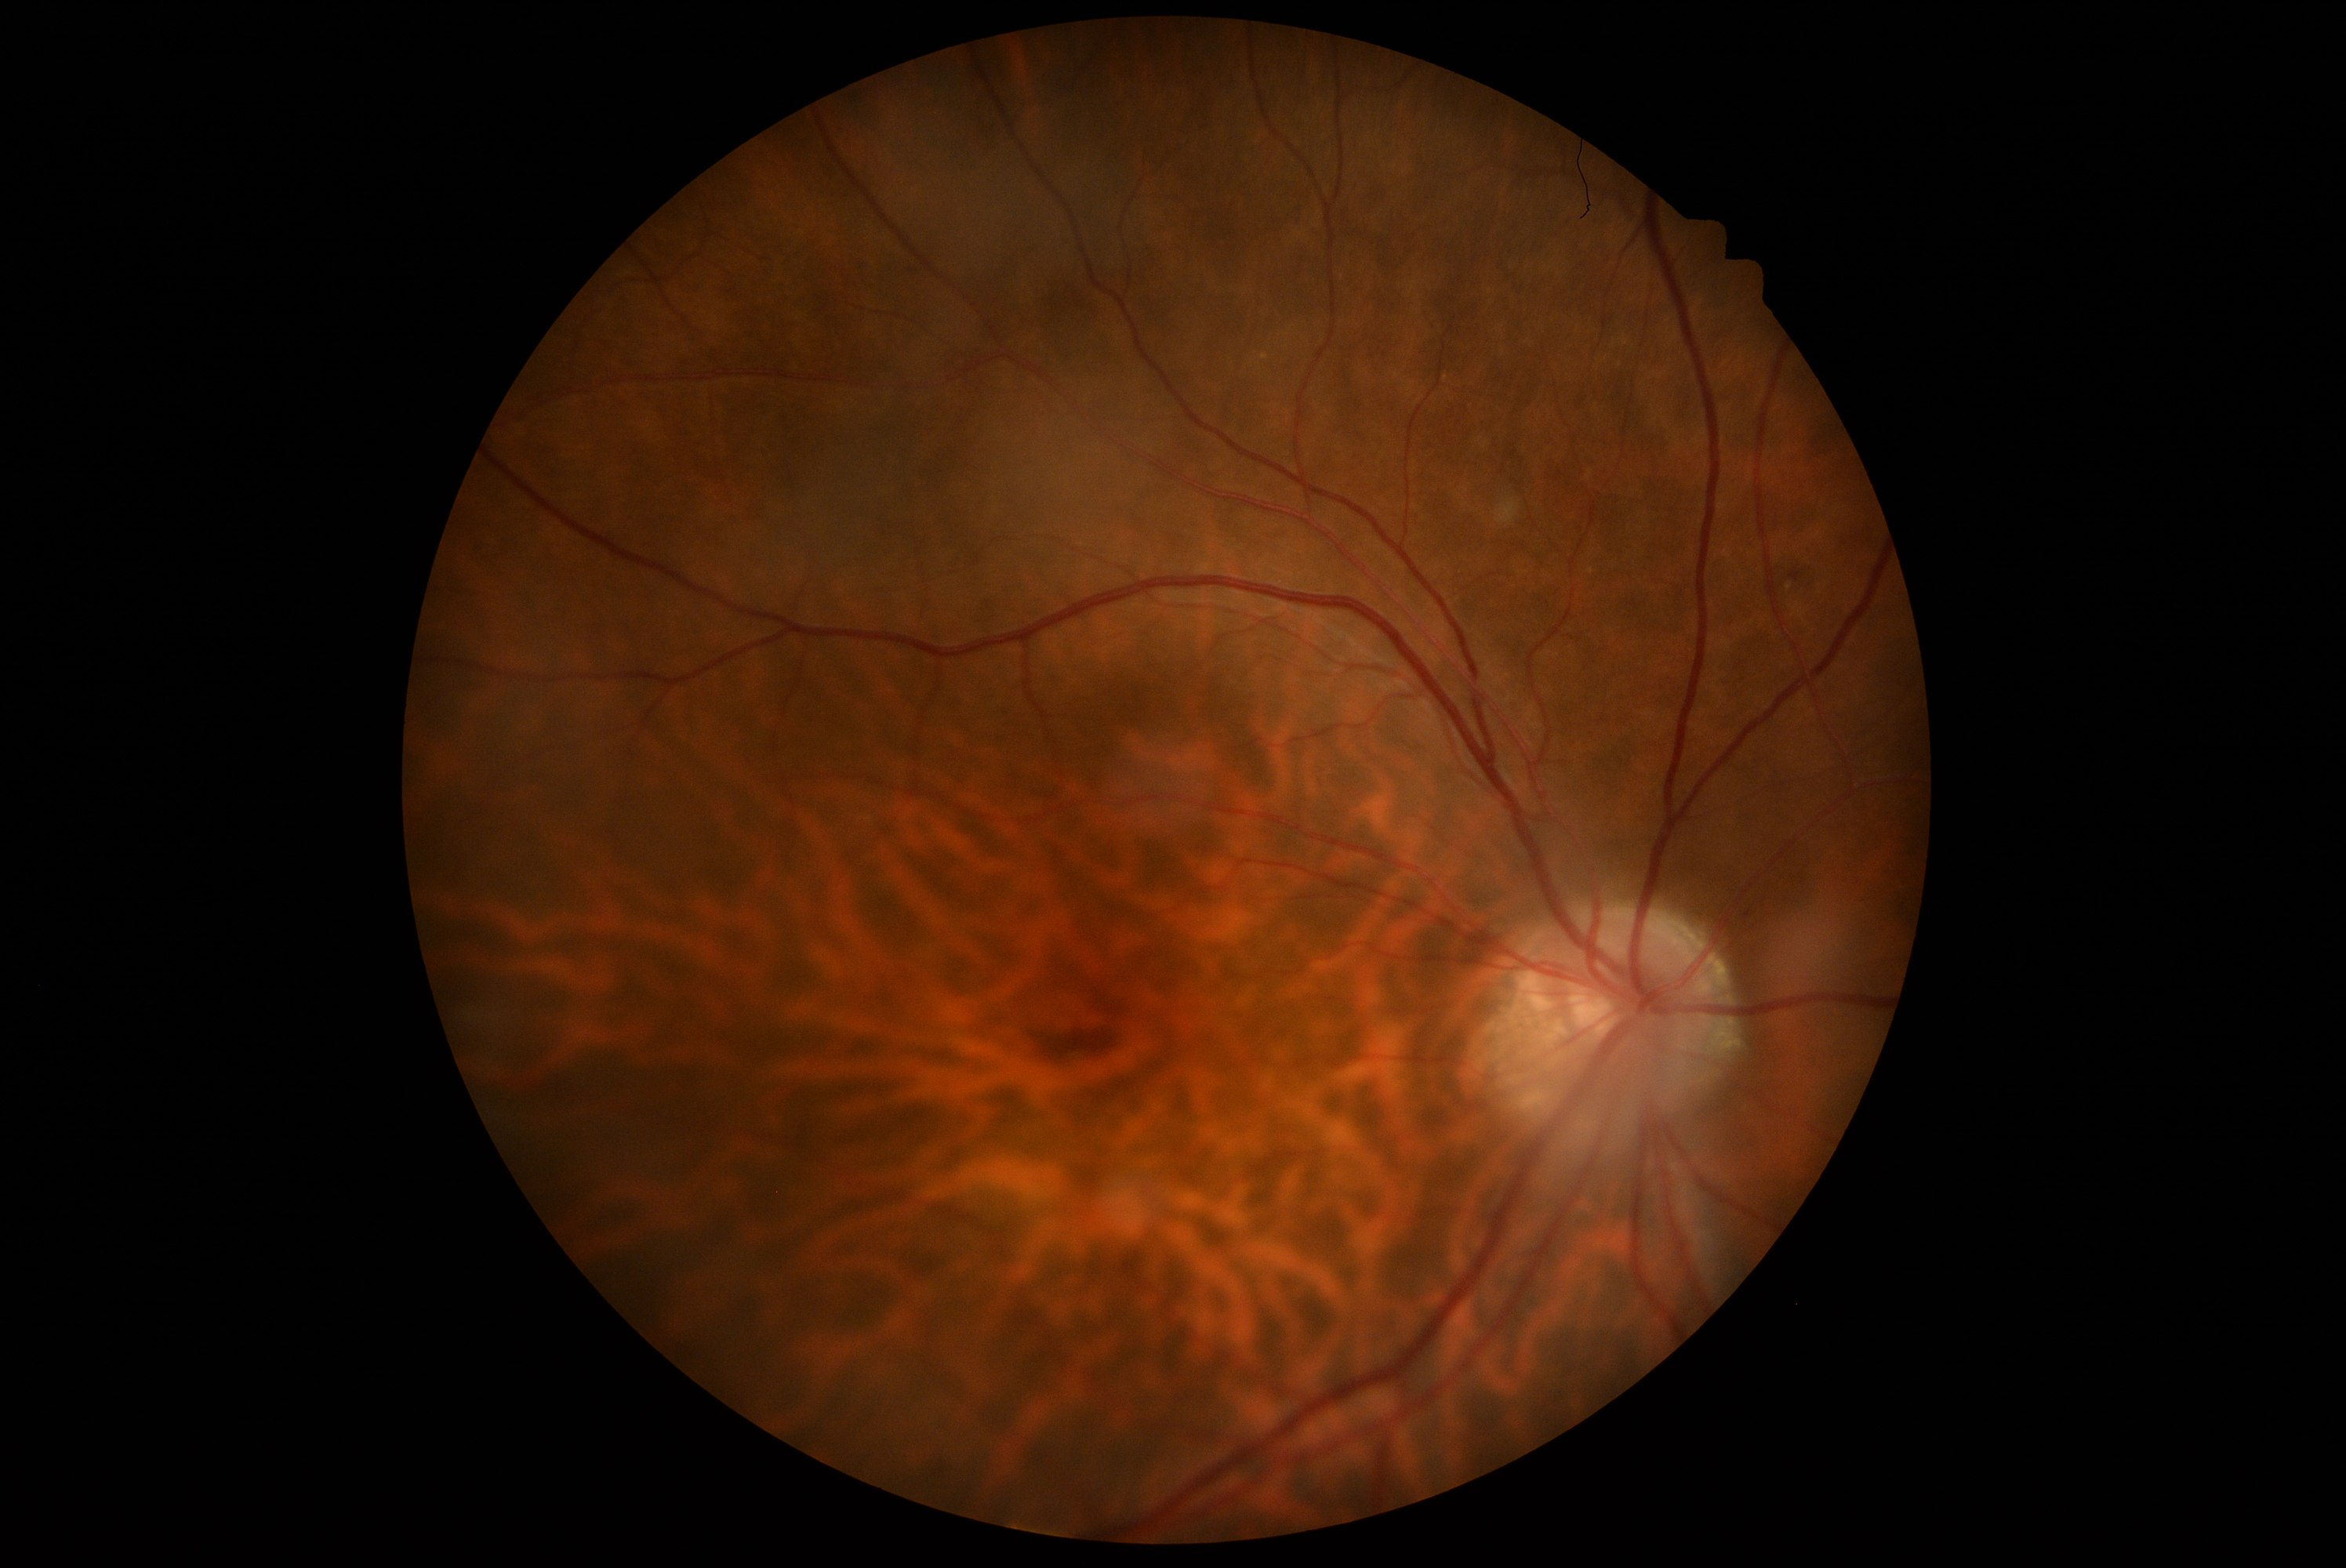

diabetic retinopathy (DR): grade 2 (moderate NPDR) — more than just microaneurysms but less than severe NPDR.